Fundus photo, 2102x1736px: 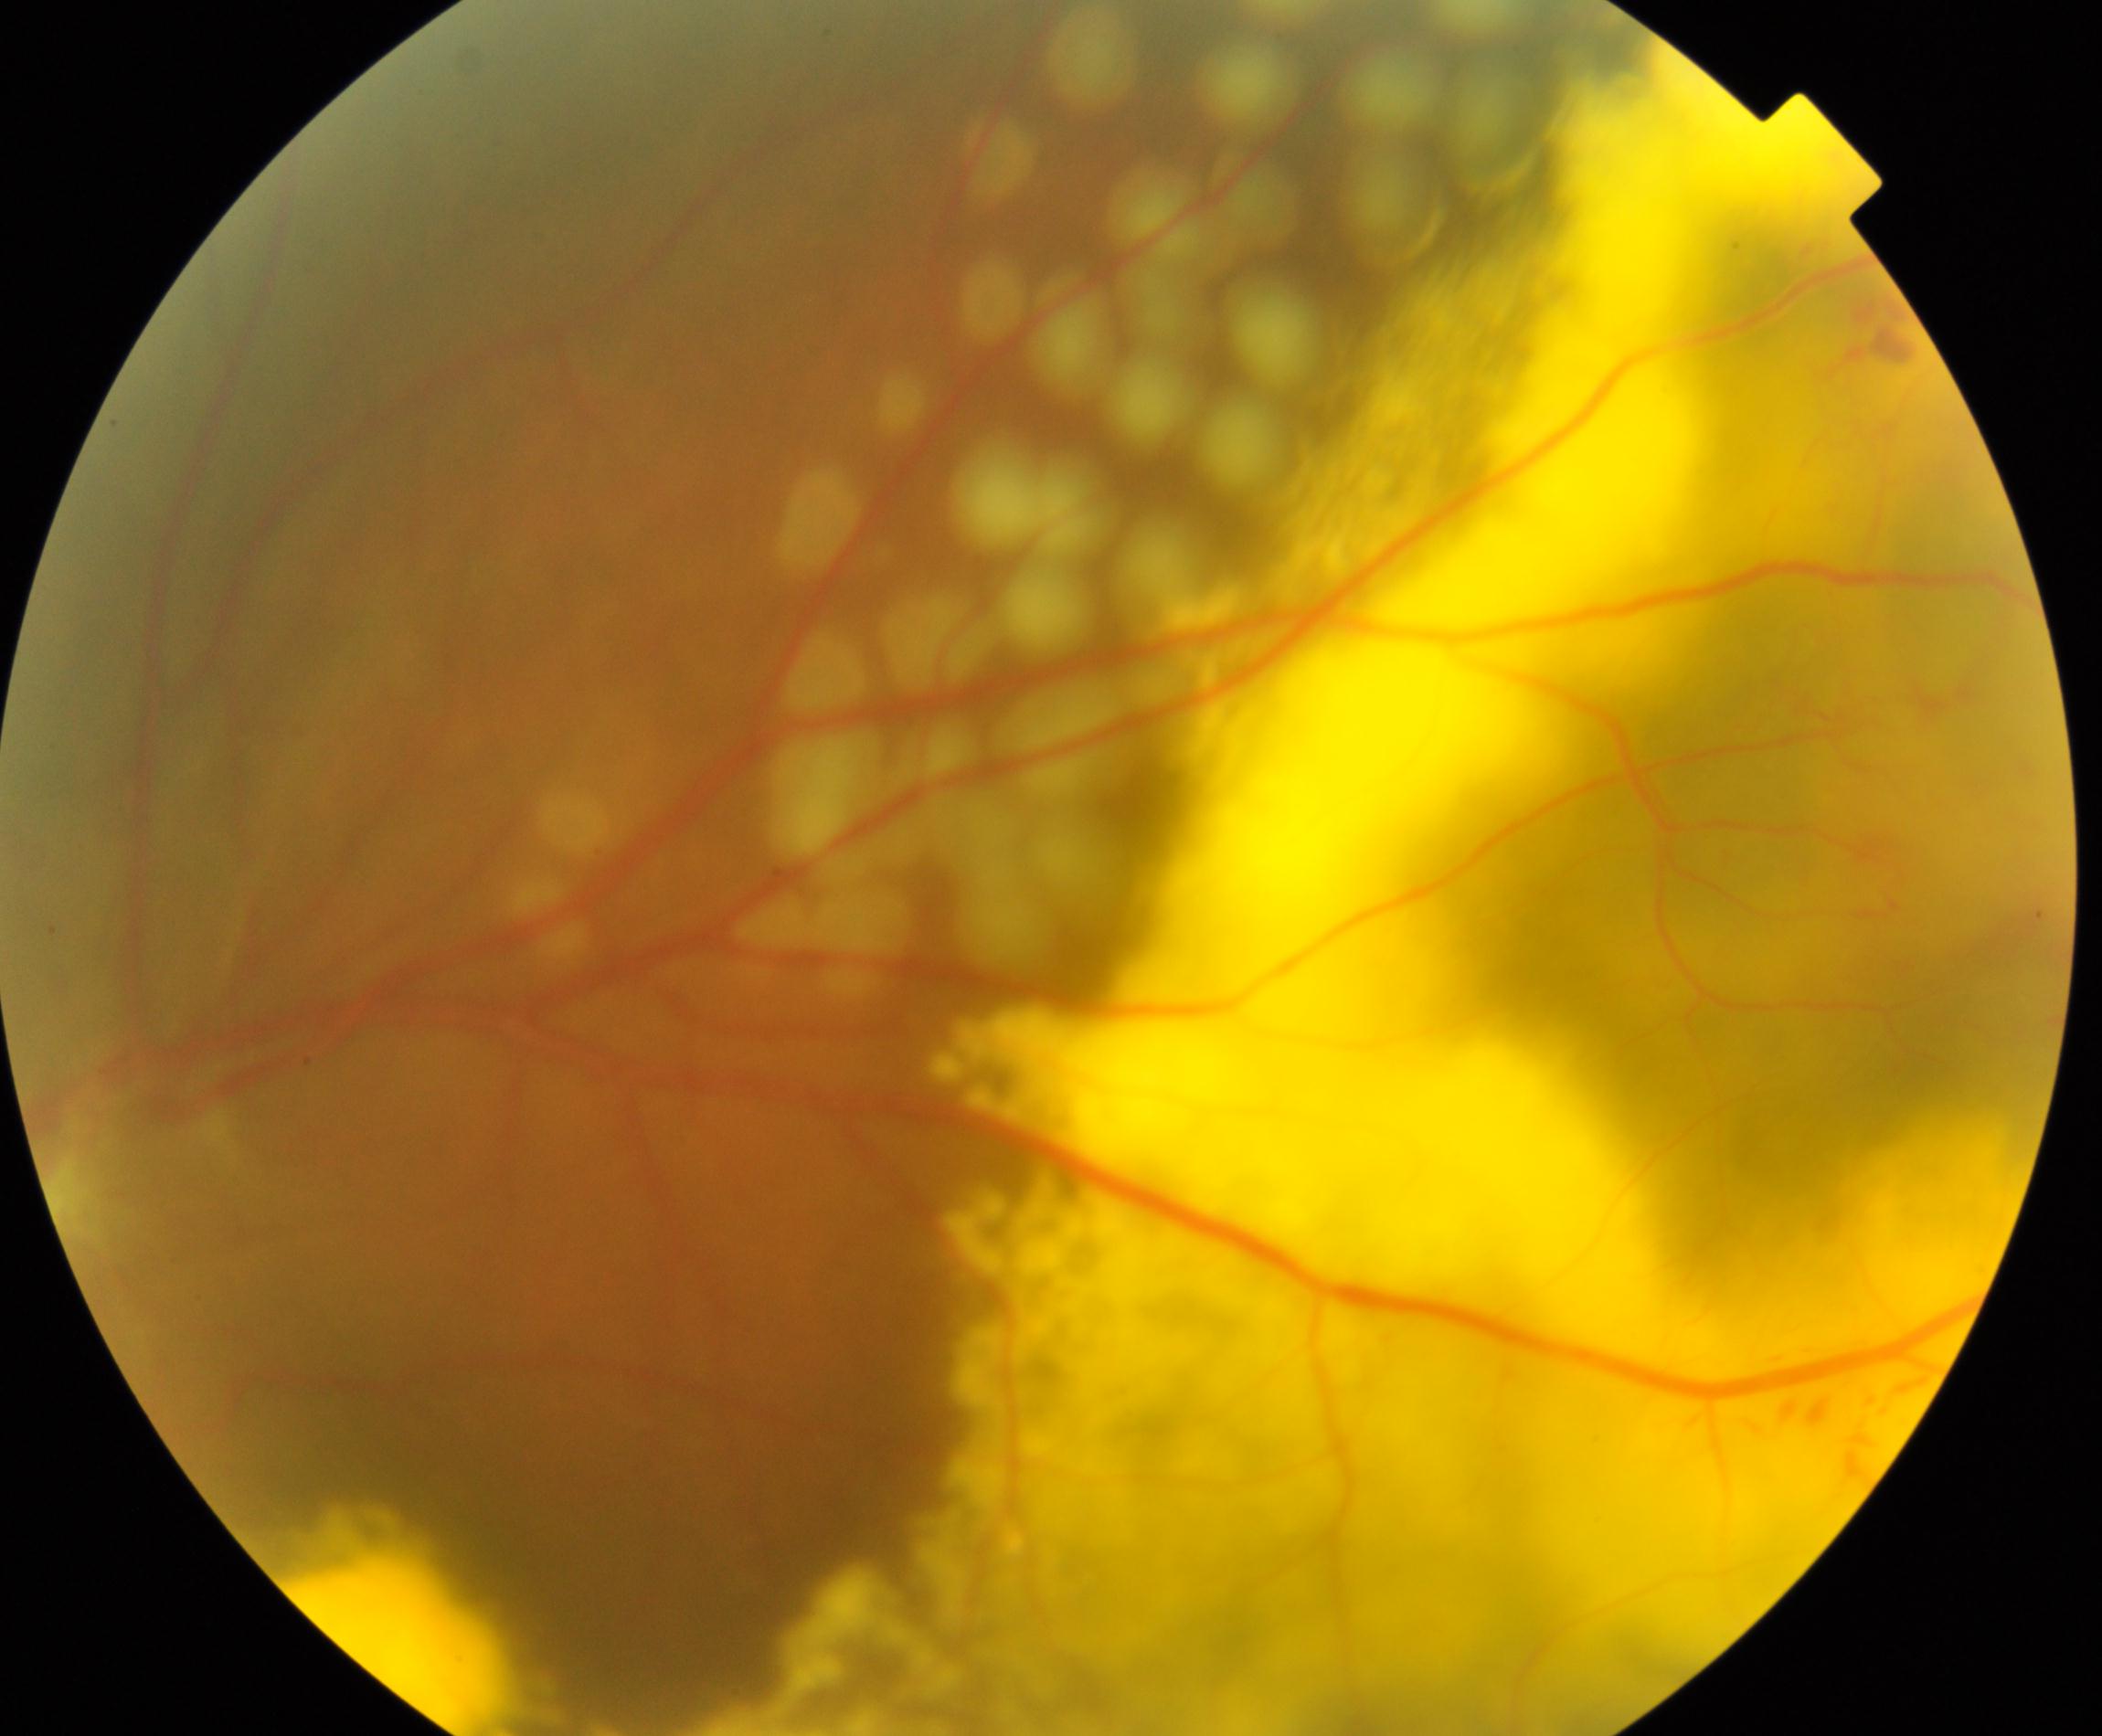 Findings consistent with massive hard exudates.